Modified Davis grading: 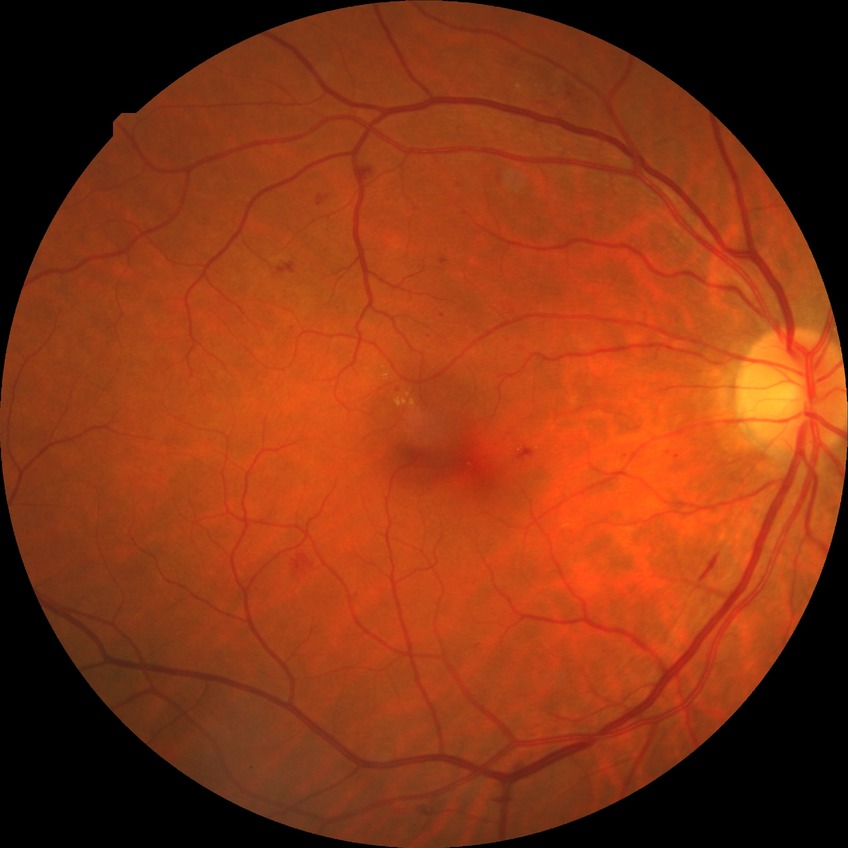

Diabetic retinopathy (DR) is PPDR (pre-proliferative diabetic retinopathy).